Image size 848x848 · NIDEK AFC-230 fundus camera · posterior pole photograph · nonmydriatic
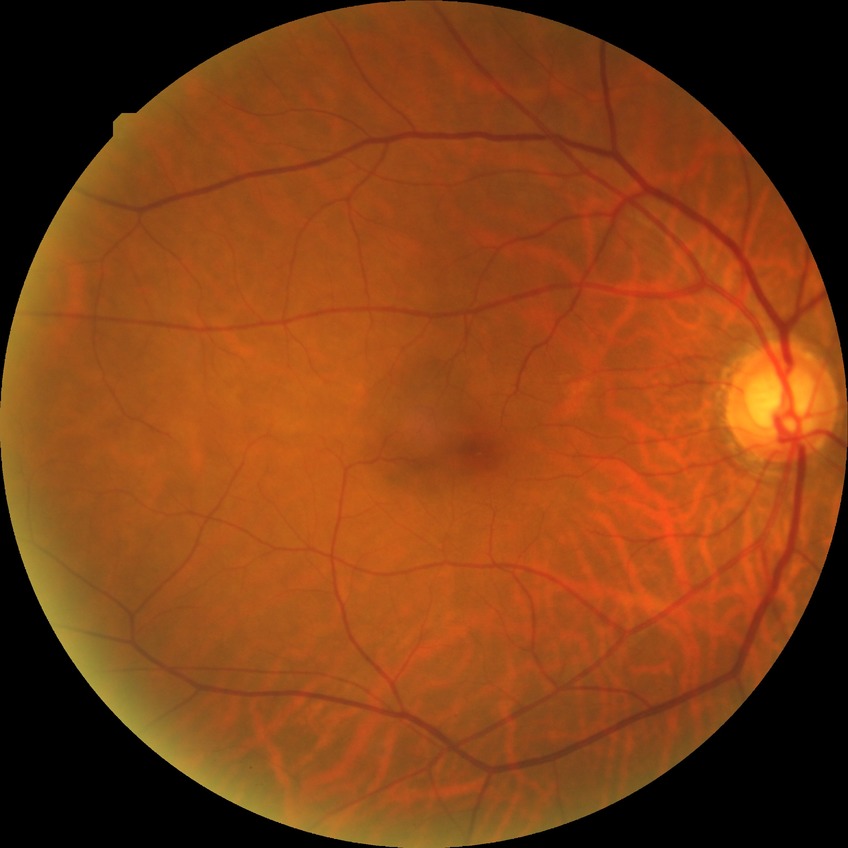
  davis_grade: no diabetic retinopathy (NDR)